1960x1897px, FOV: 45 degrees, color fundus image:
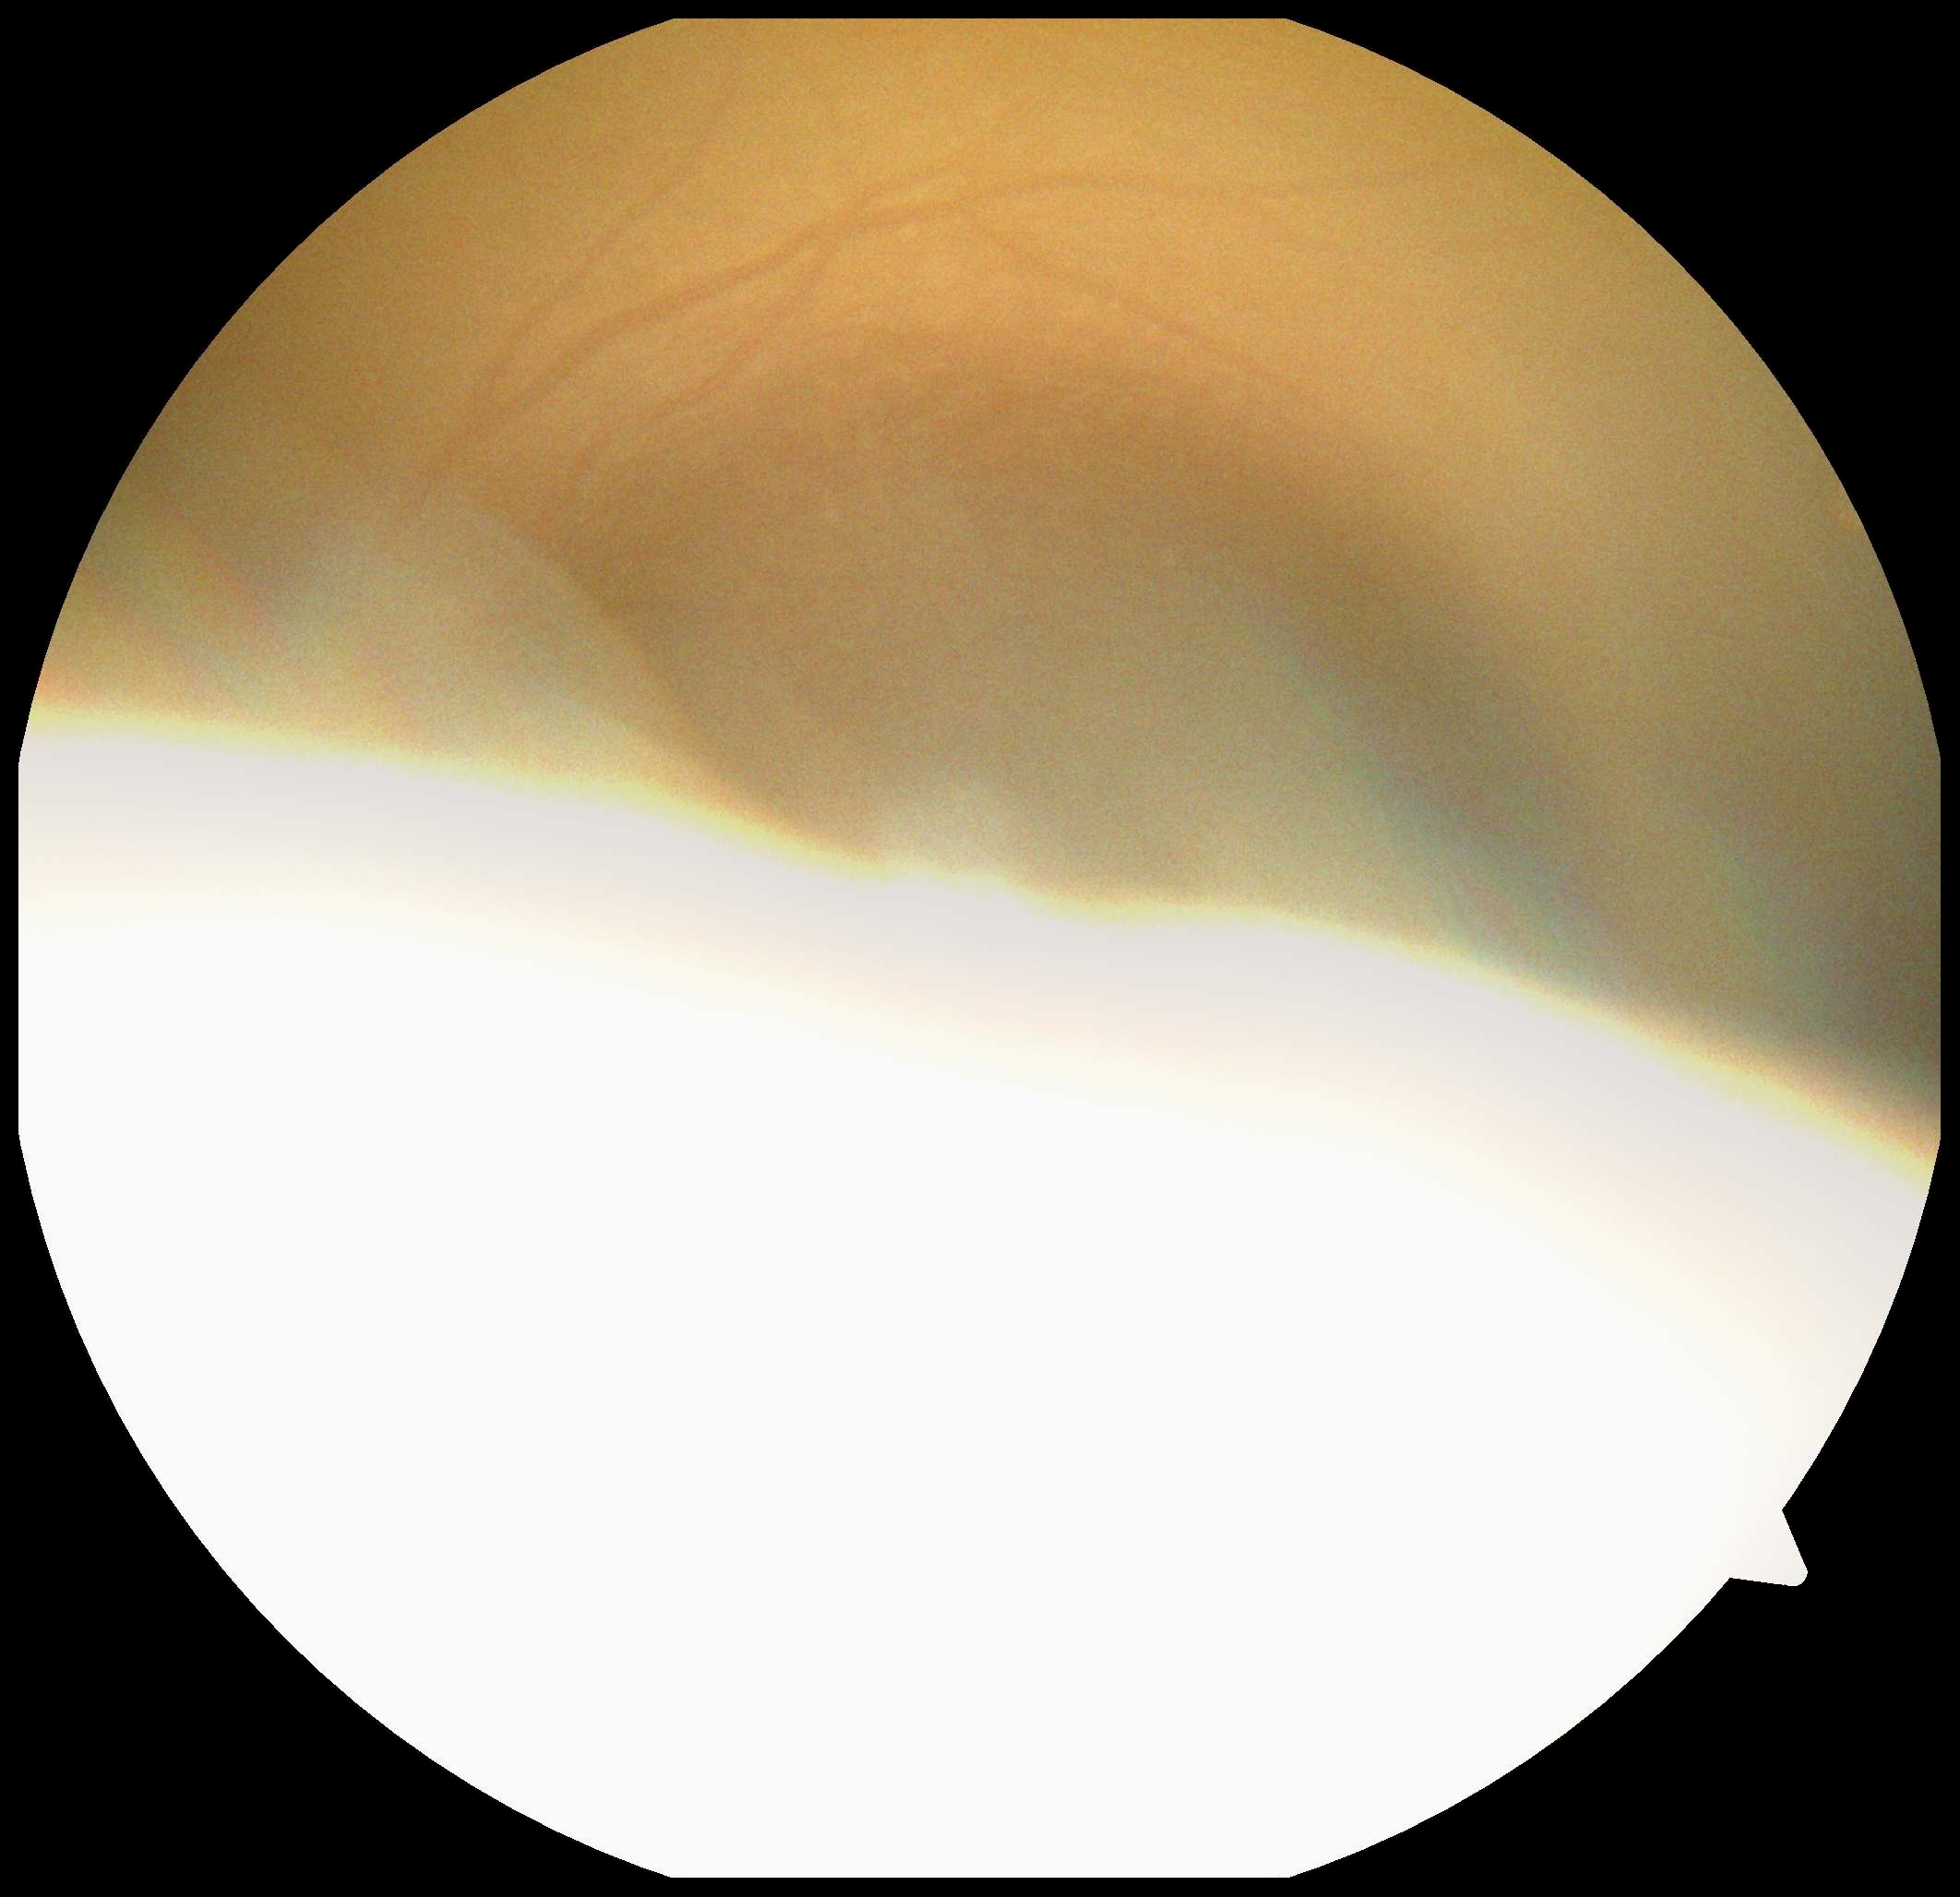

- DR severity — ungradable due to poor image quality
- image quality — insufficient